RetCam wide-field infant fundus image; image size 640x480:
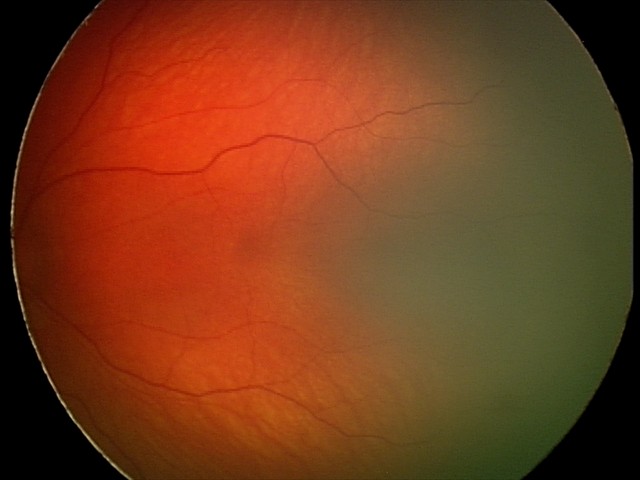 Series diagnosed as retinal hemorrhages.